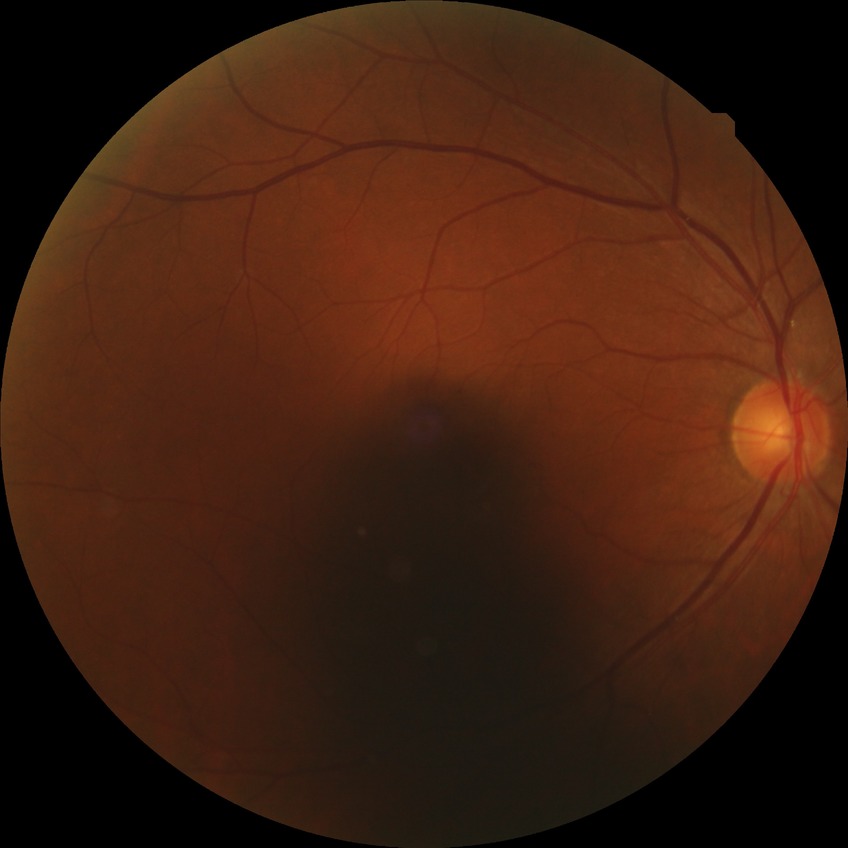 Modified Davis grading is no diabetic retinopathy.